1240x1240px; infant wide-field fundus photograph.
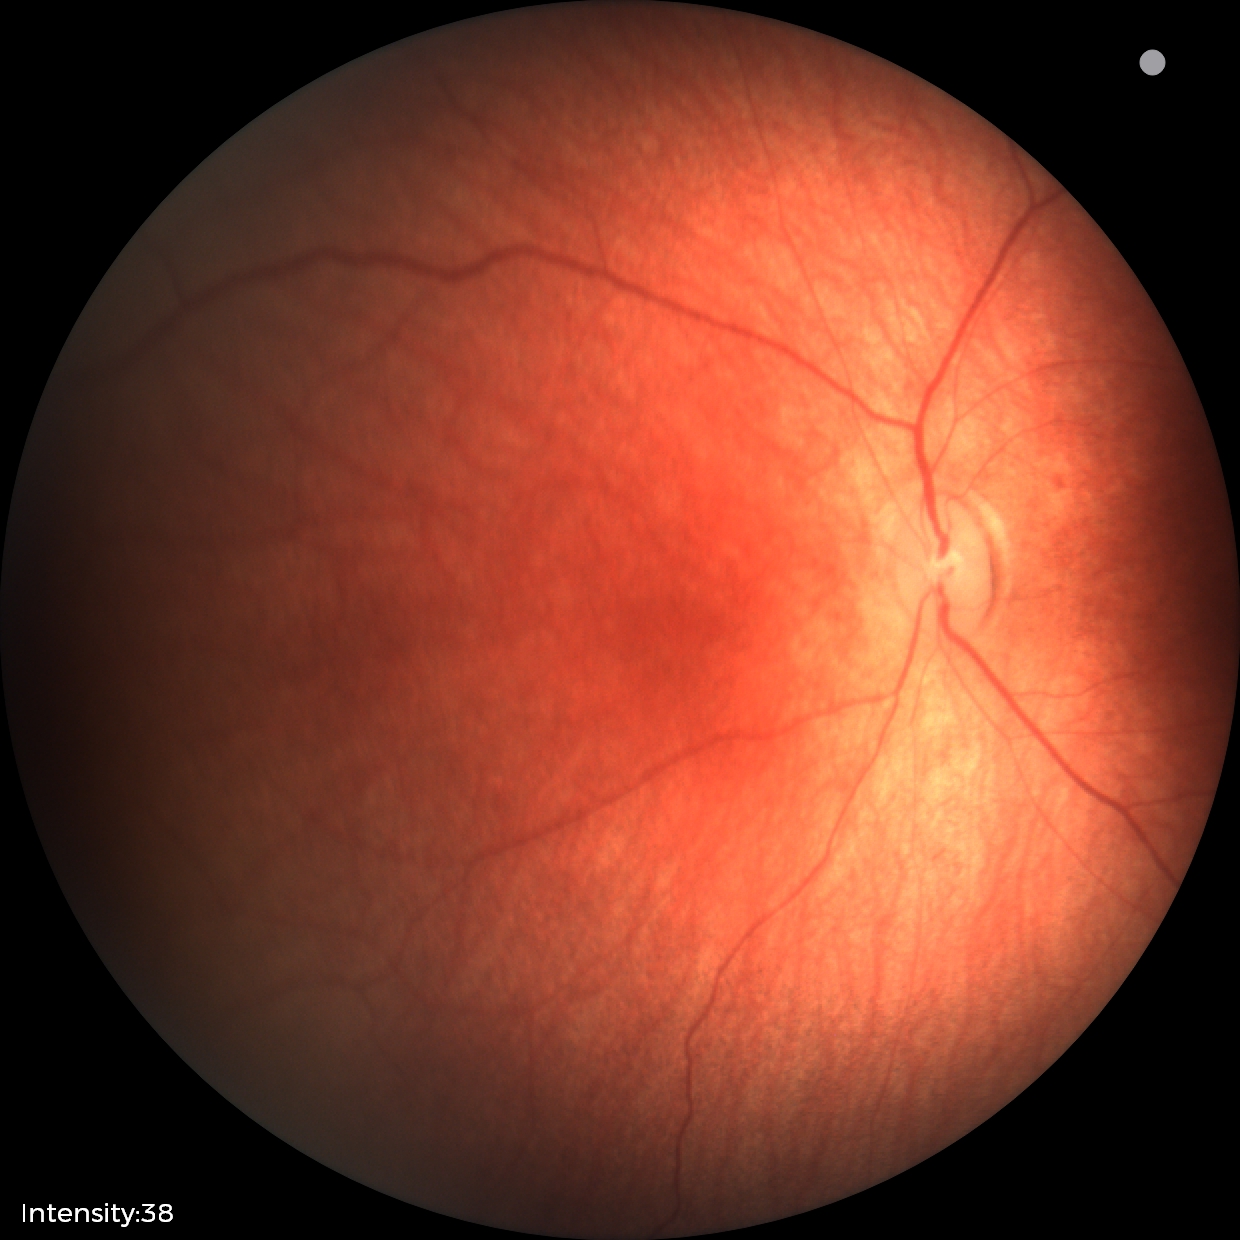

No retinal pathology identified on screening.